45° FOV.
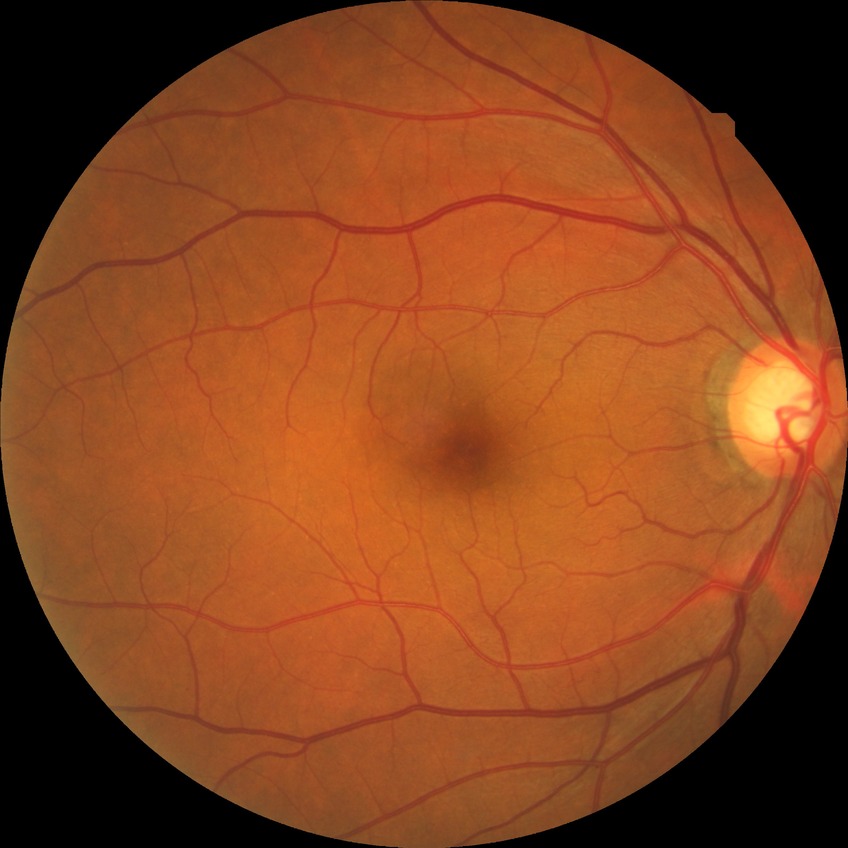
davis_grade: no diabetic retinopathy